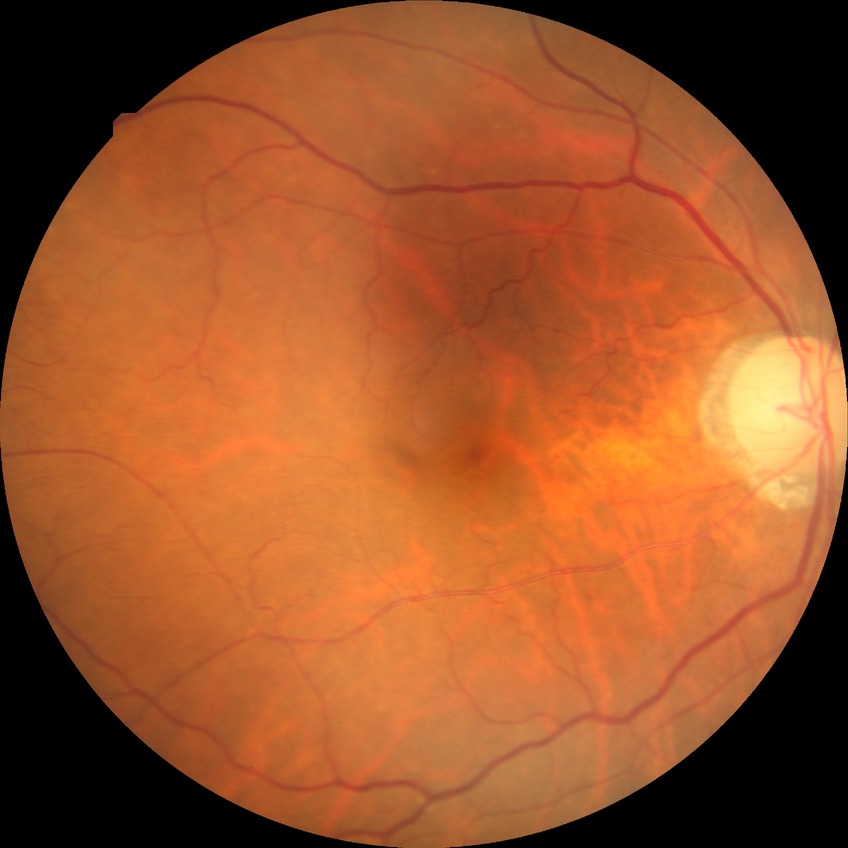
Diabetic retinopathy (DR) is NDR (no diabetic retinopathy).